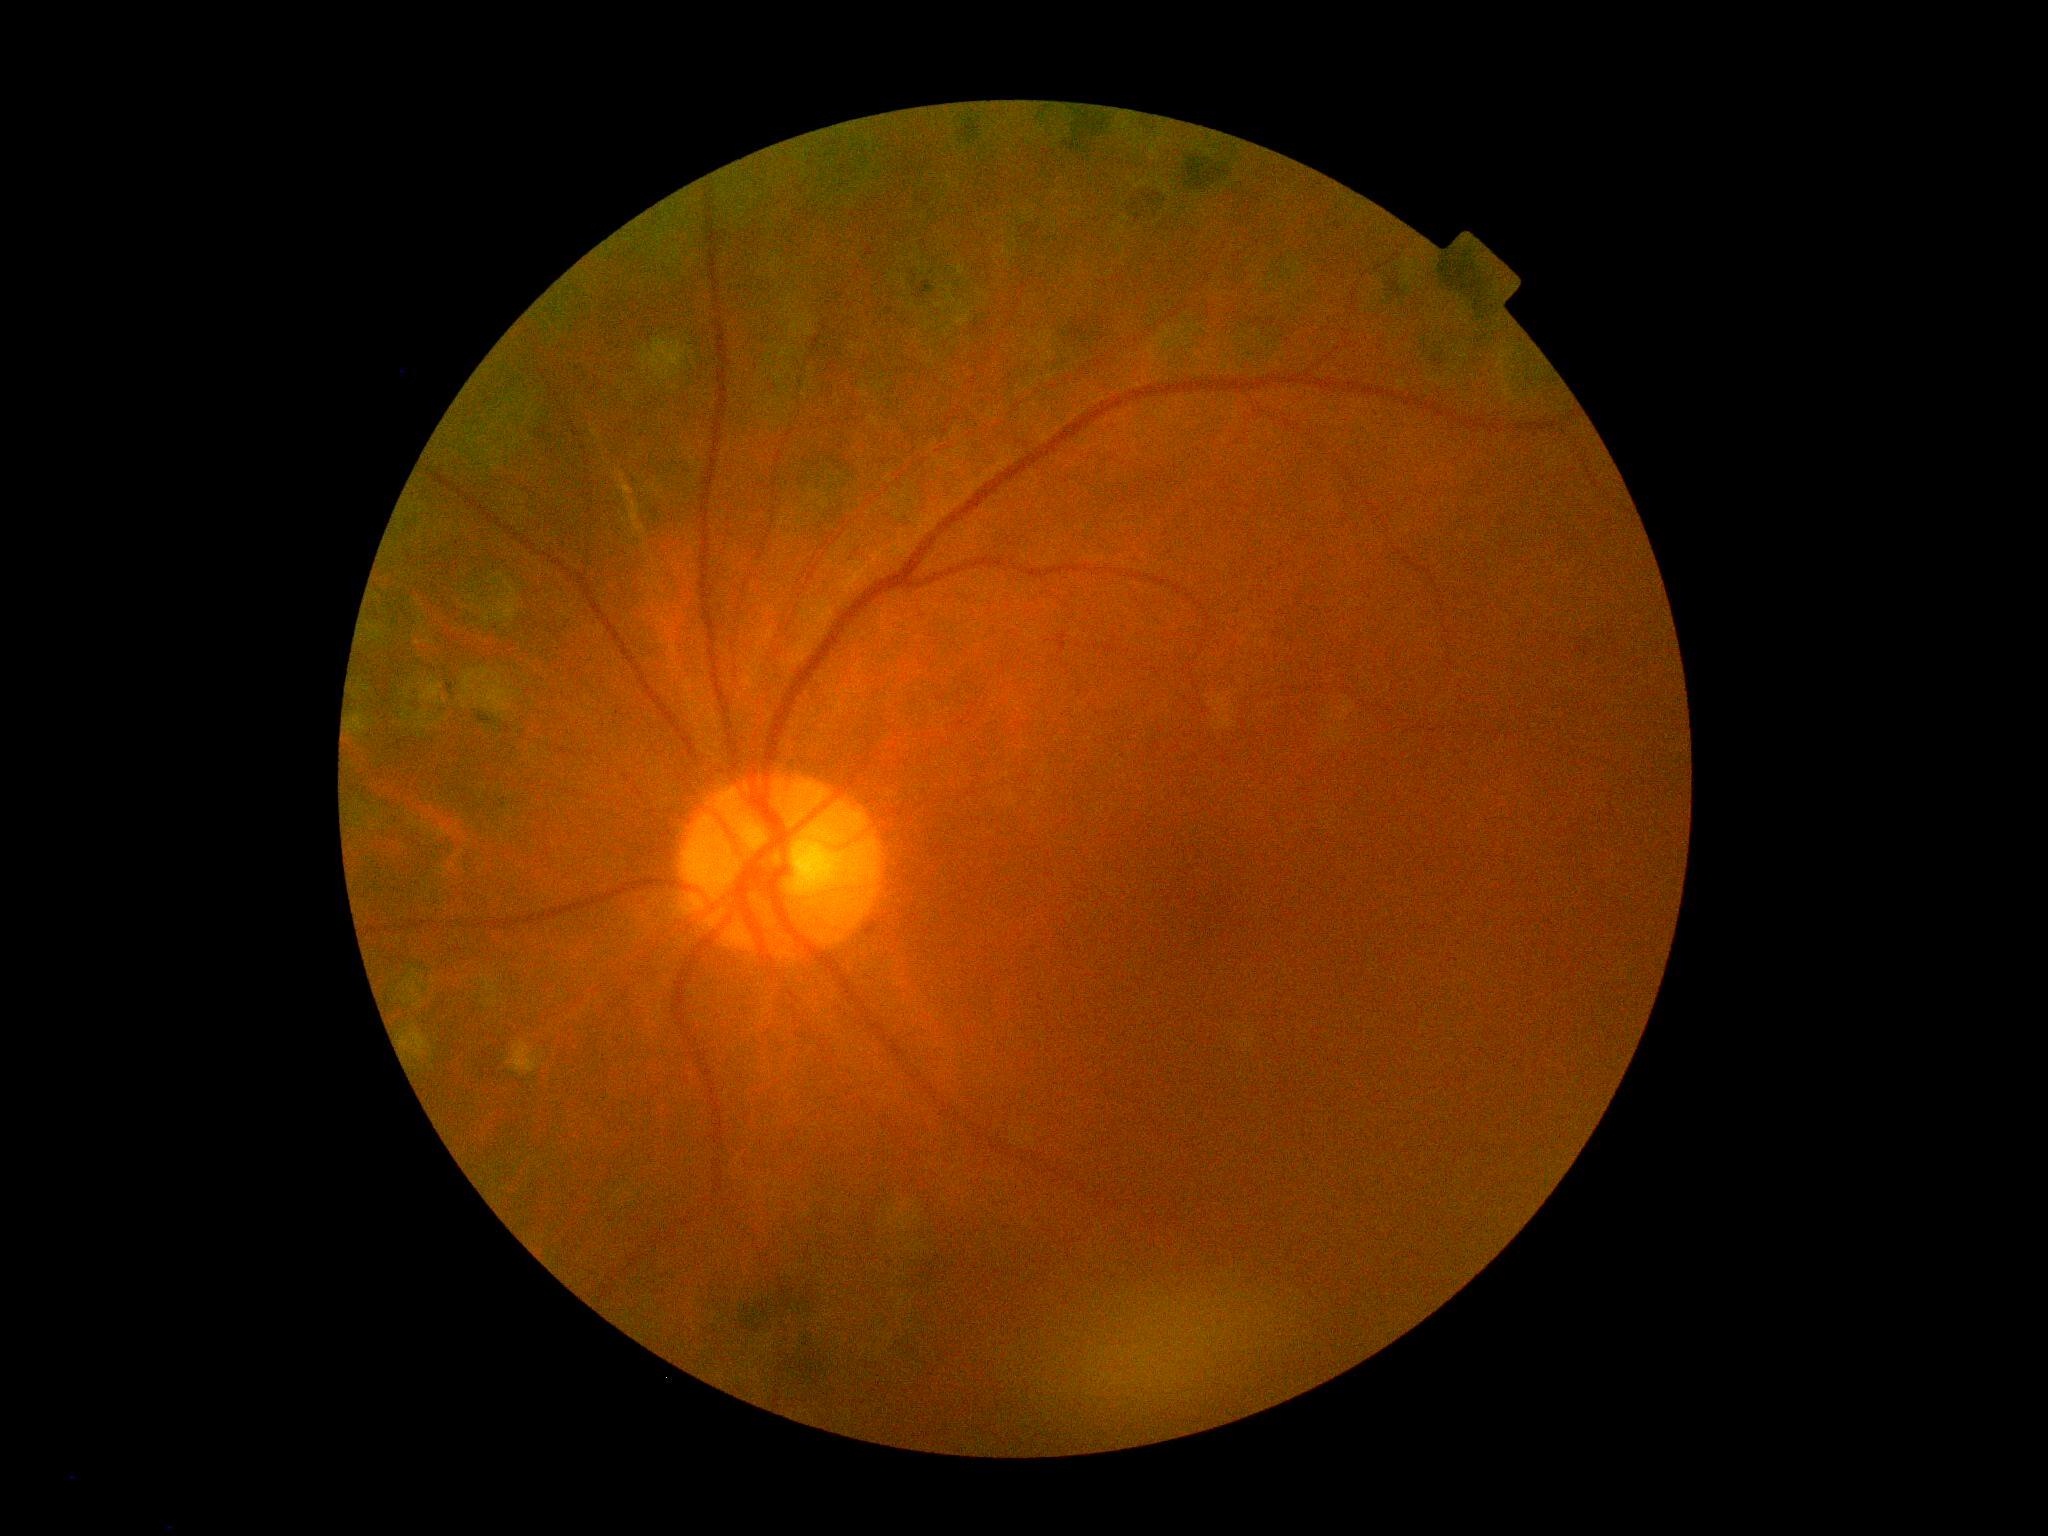

Diabetic retinopathy (DR) is grade 2 (moderate NPDR).